50-degree field of view:
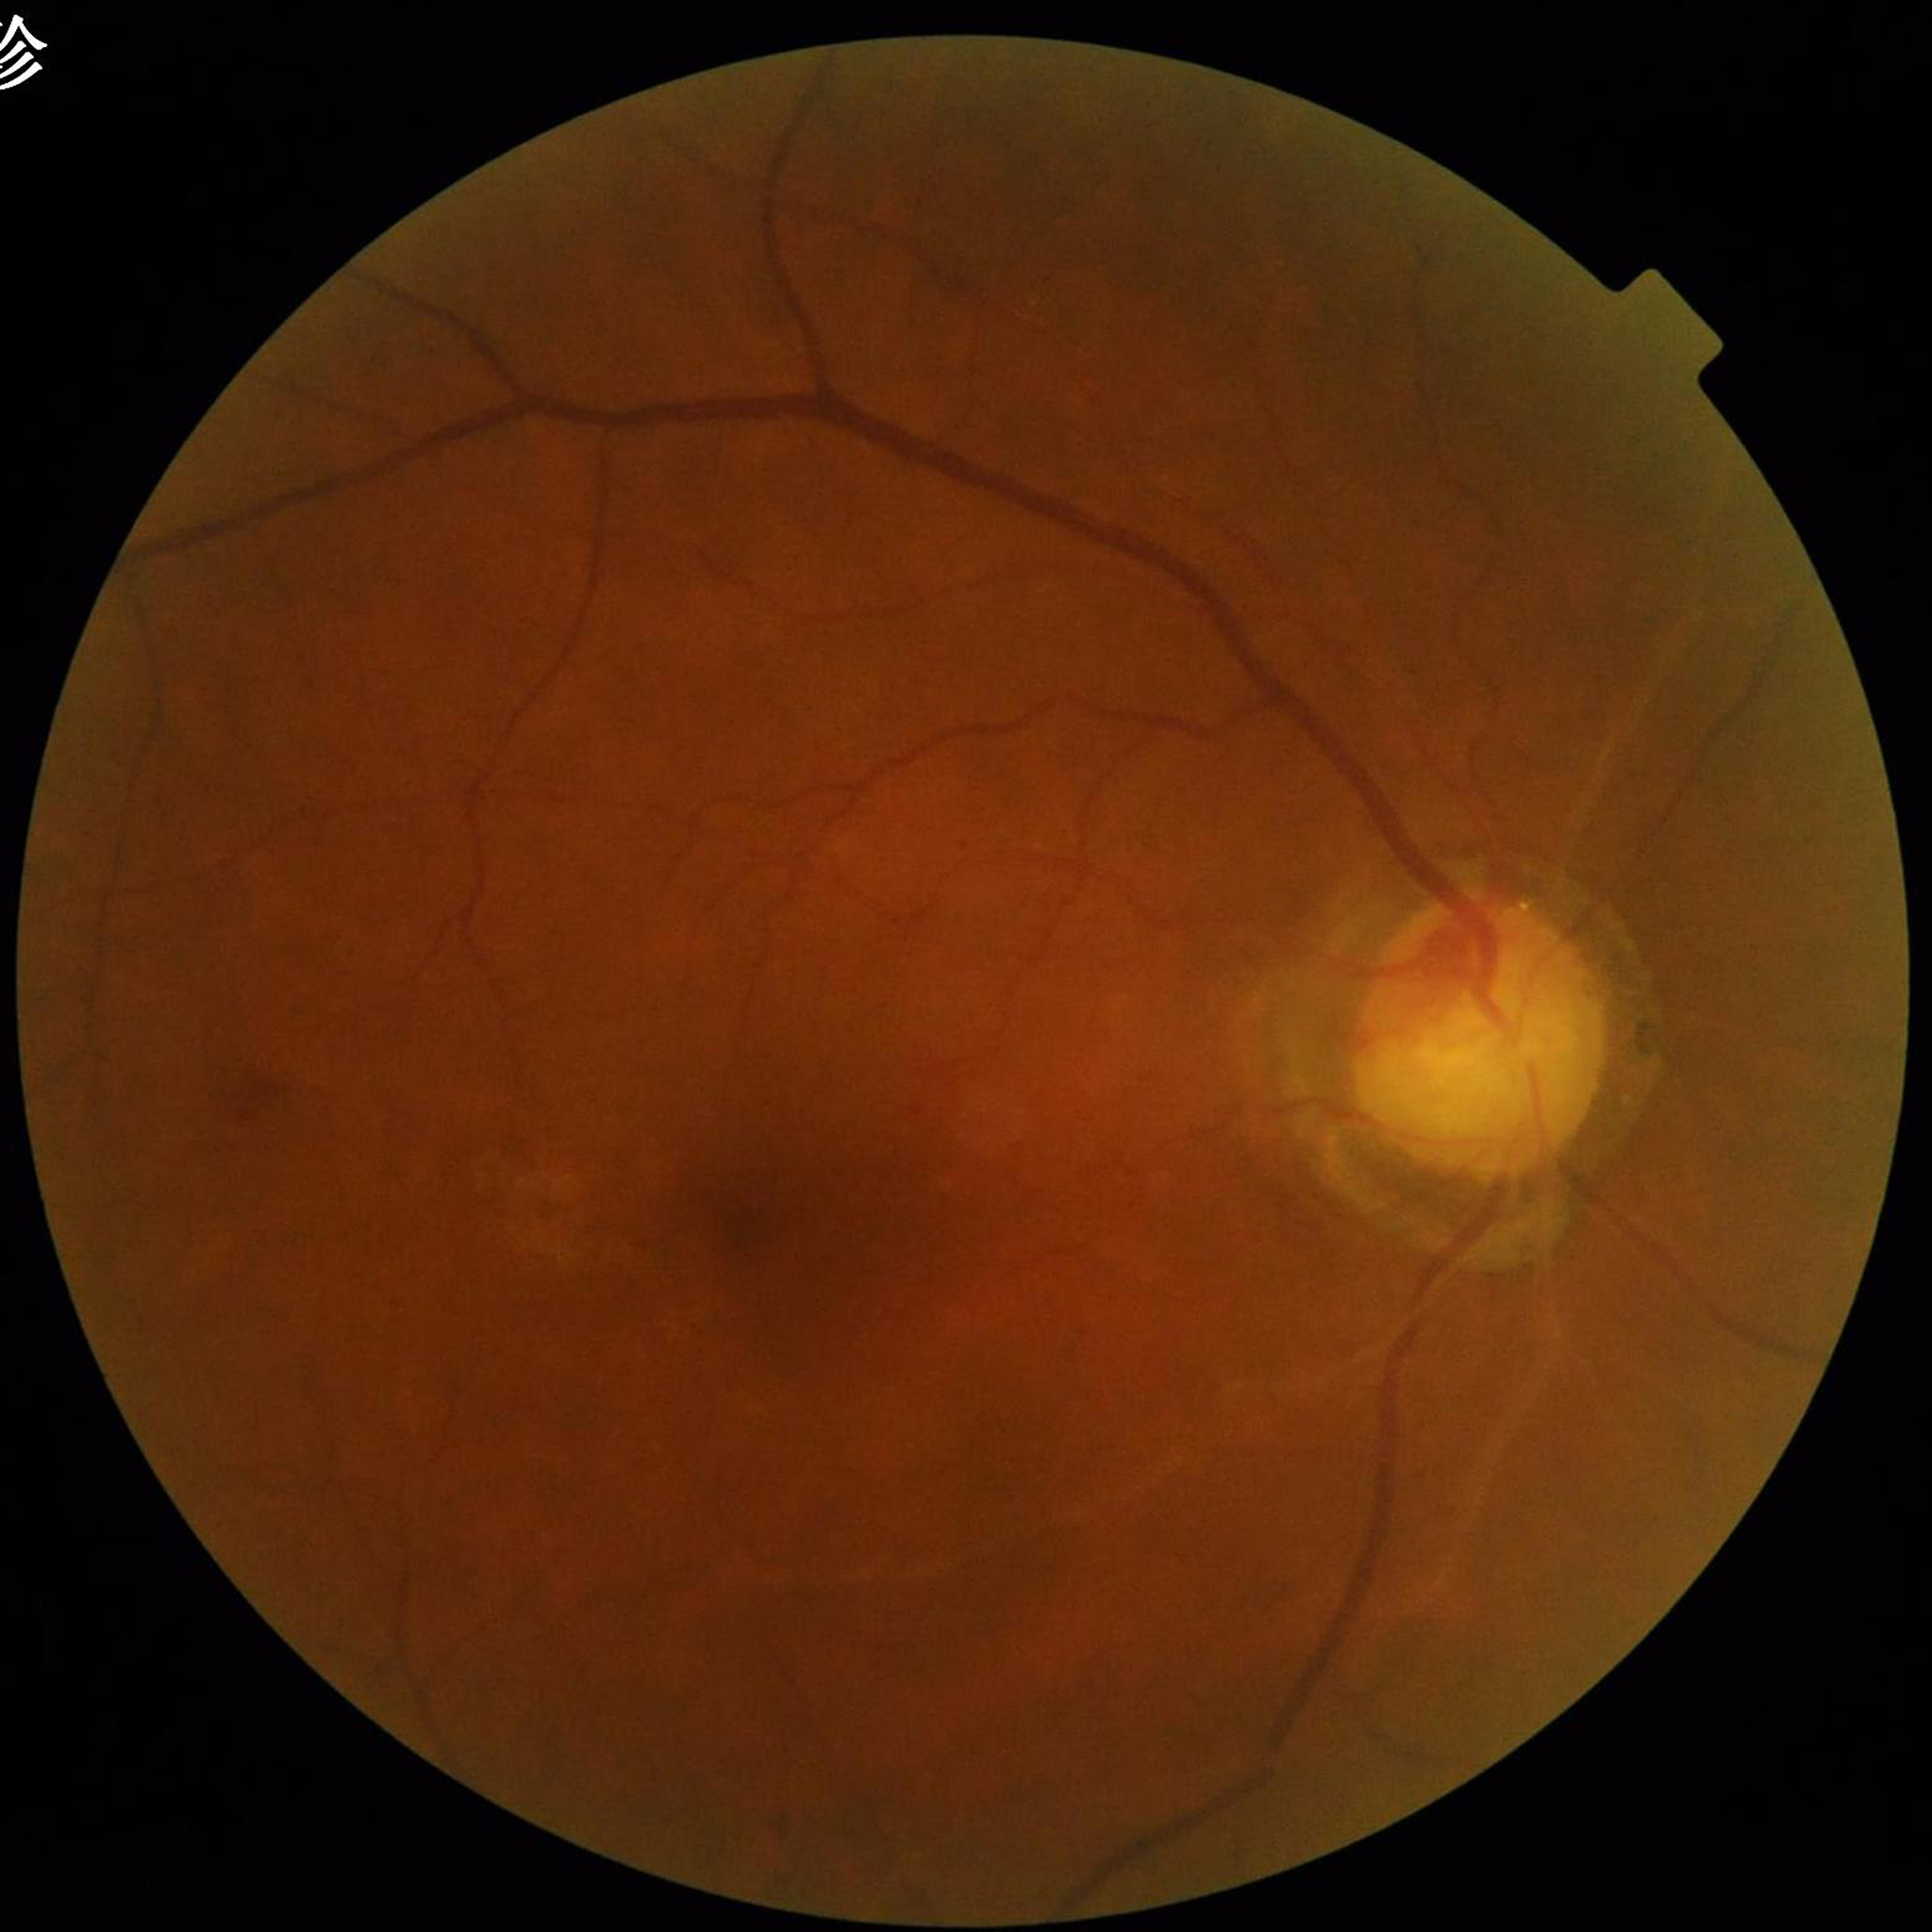 Photo quality: good.
Fundus image of an eye with diabetic retinopathy.